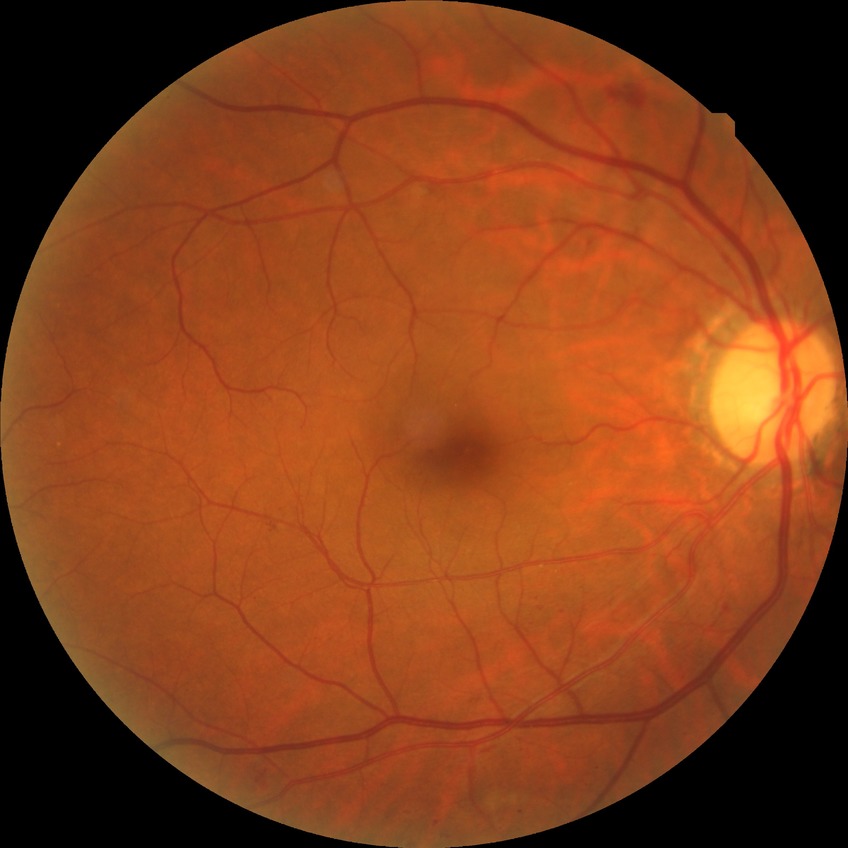

Diabetic retinopathy (DR): SDR (simple diabetic retinopathy).